FOV: 45 degrees:
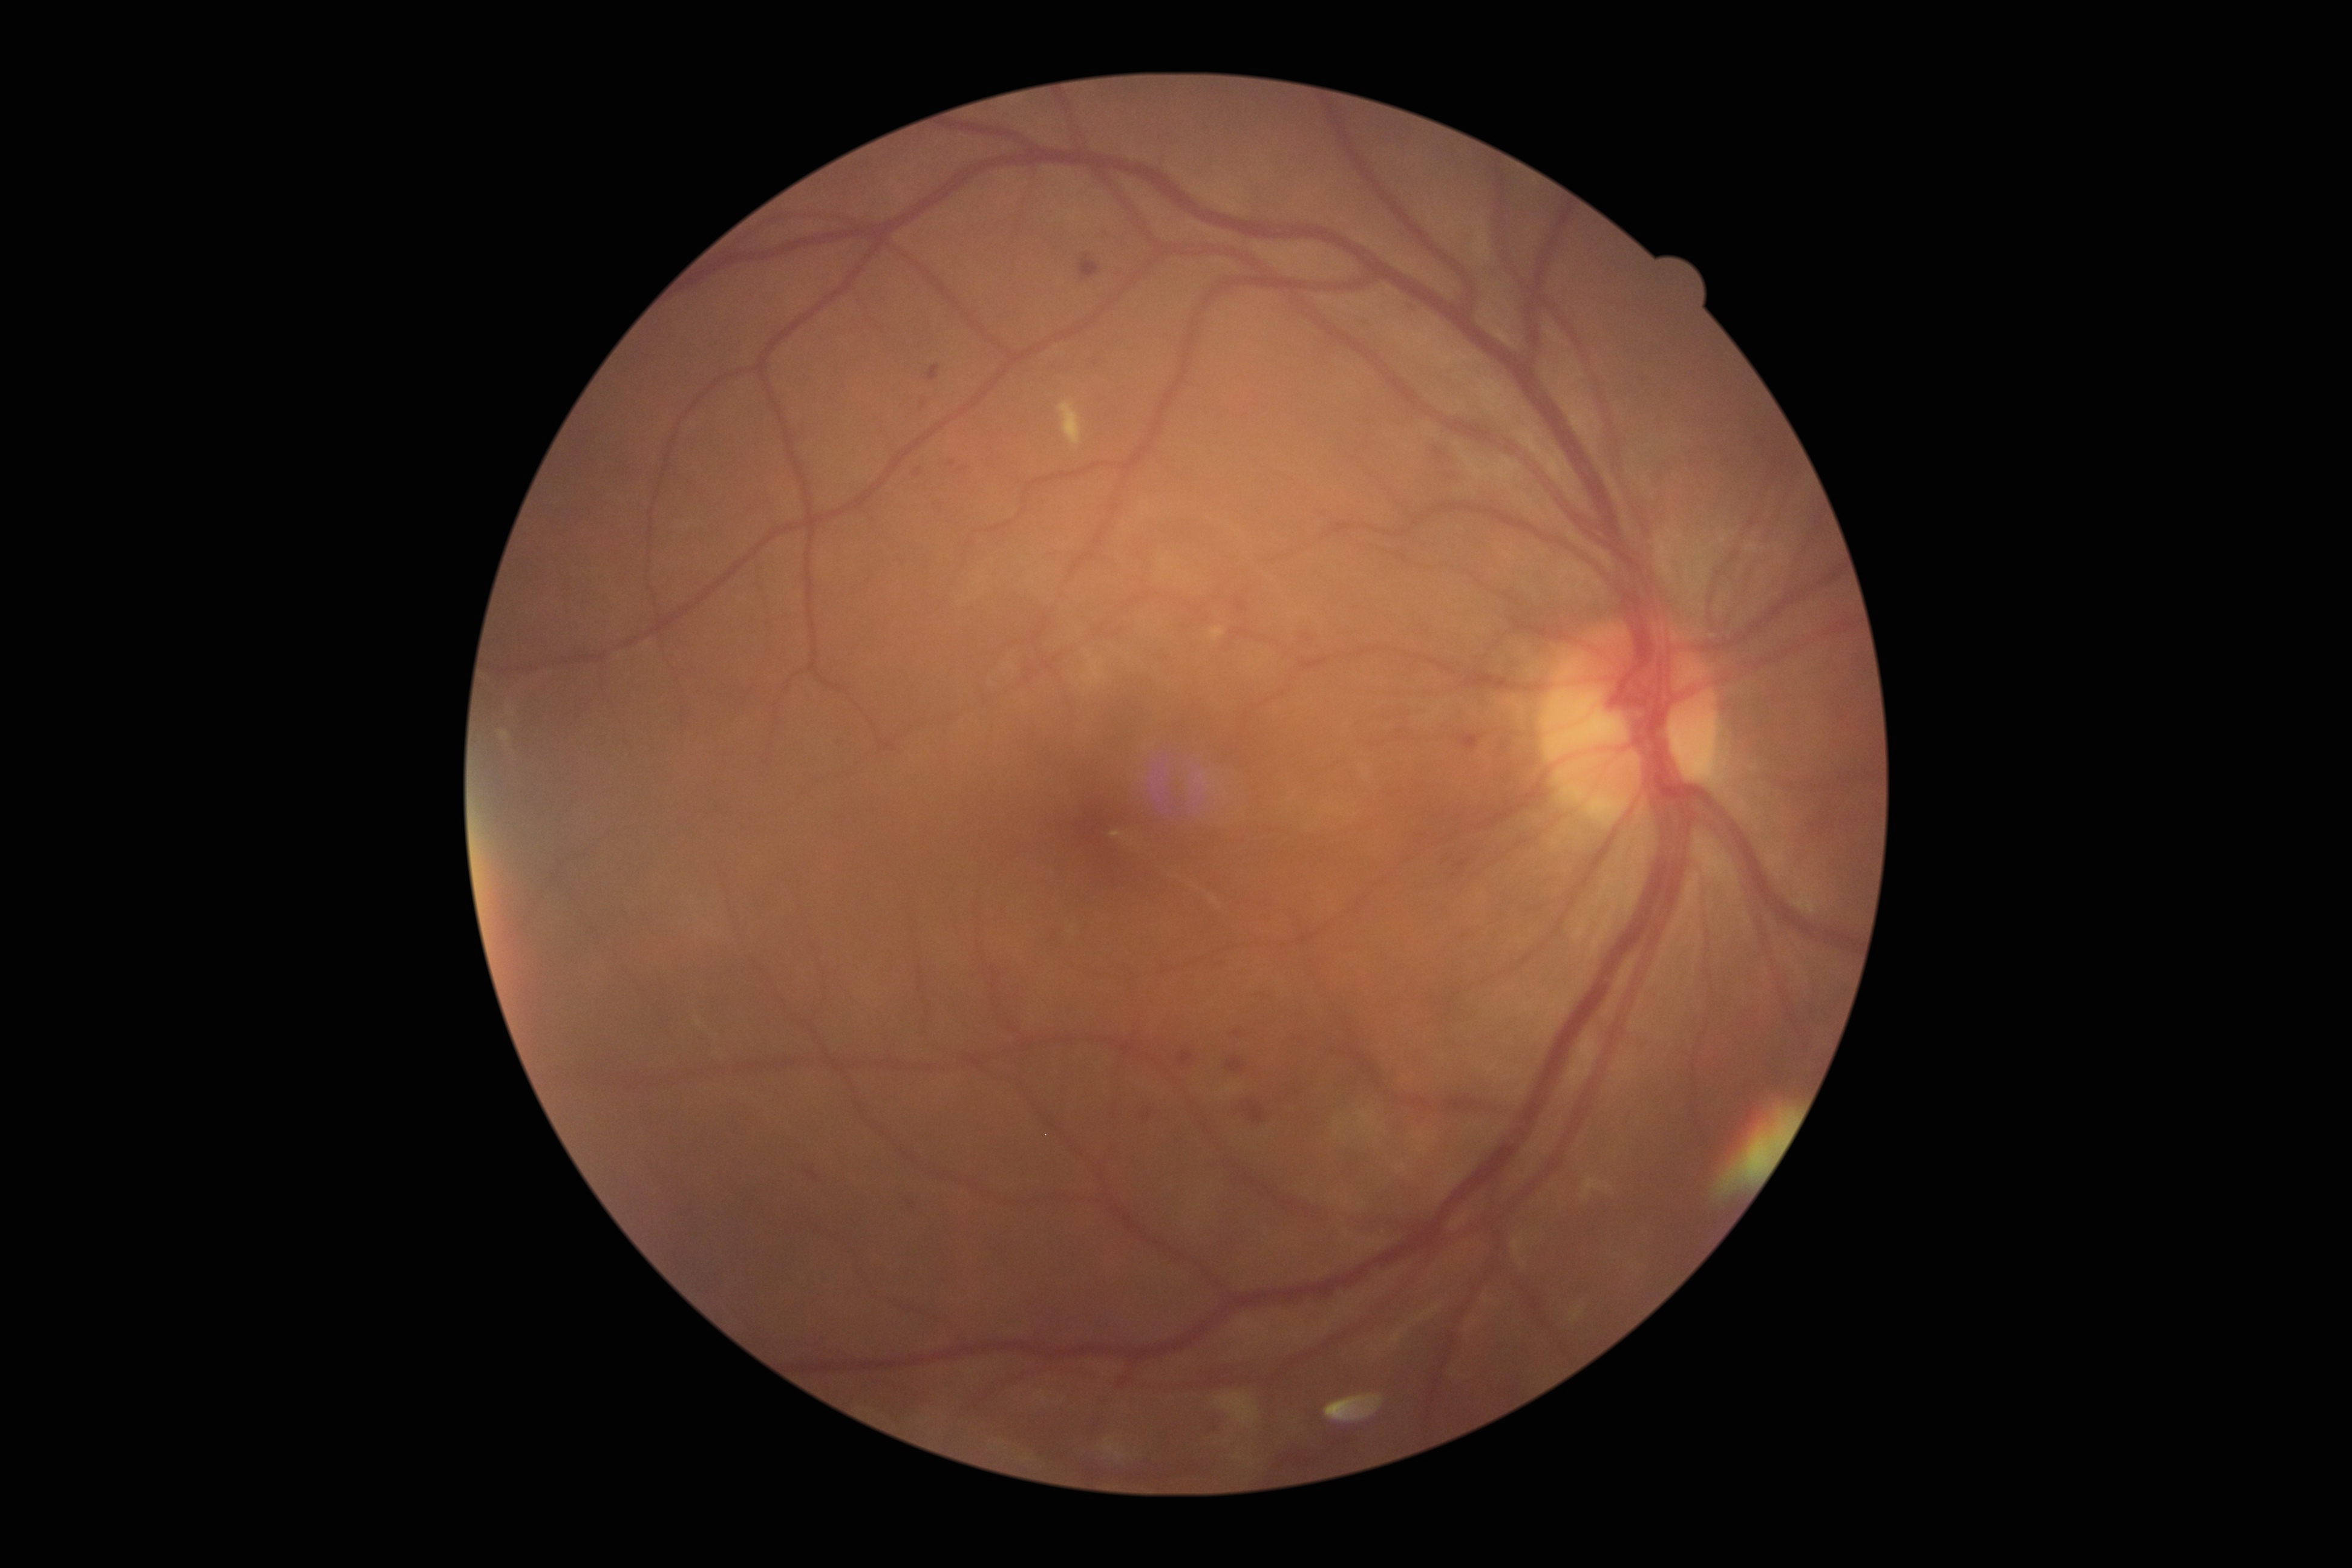

DR severity@grade 2 — more than just microaneurysms but less than severe NPDR.